Wide-field fundus photograph of an infant · 130° field of view (Clarity RetCam 3) · image size 640x480:
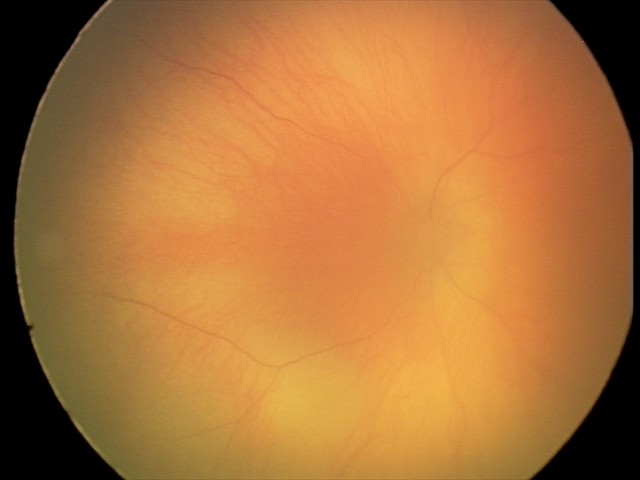

Q: What is the screening diagnosis?
A: physiological retinal finding